Phoenix ICON wide-field infant fundus image. Acquired on the Phoenix ICON — 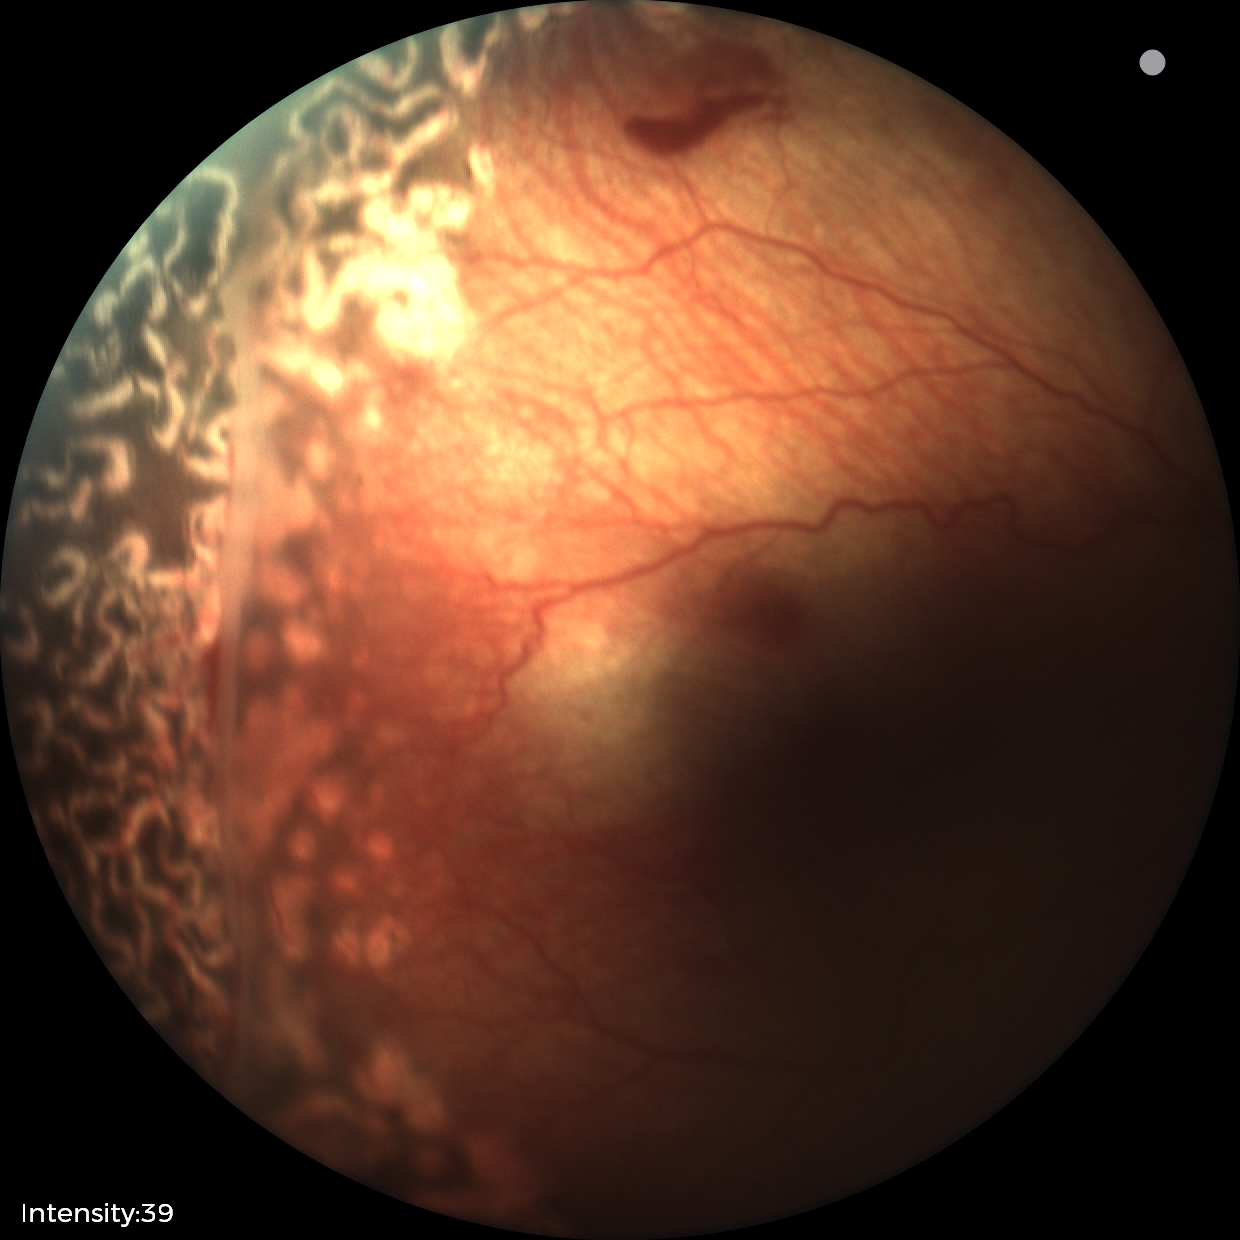

Assessment: no plus disease | status post ROP.